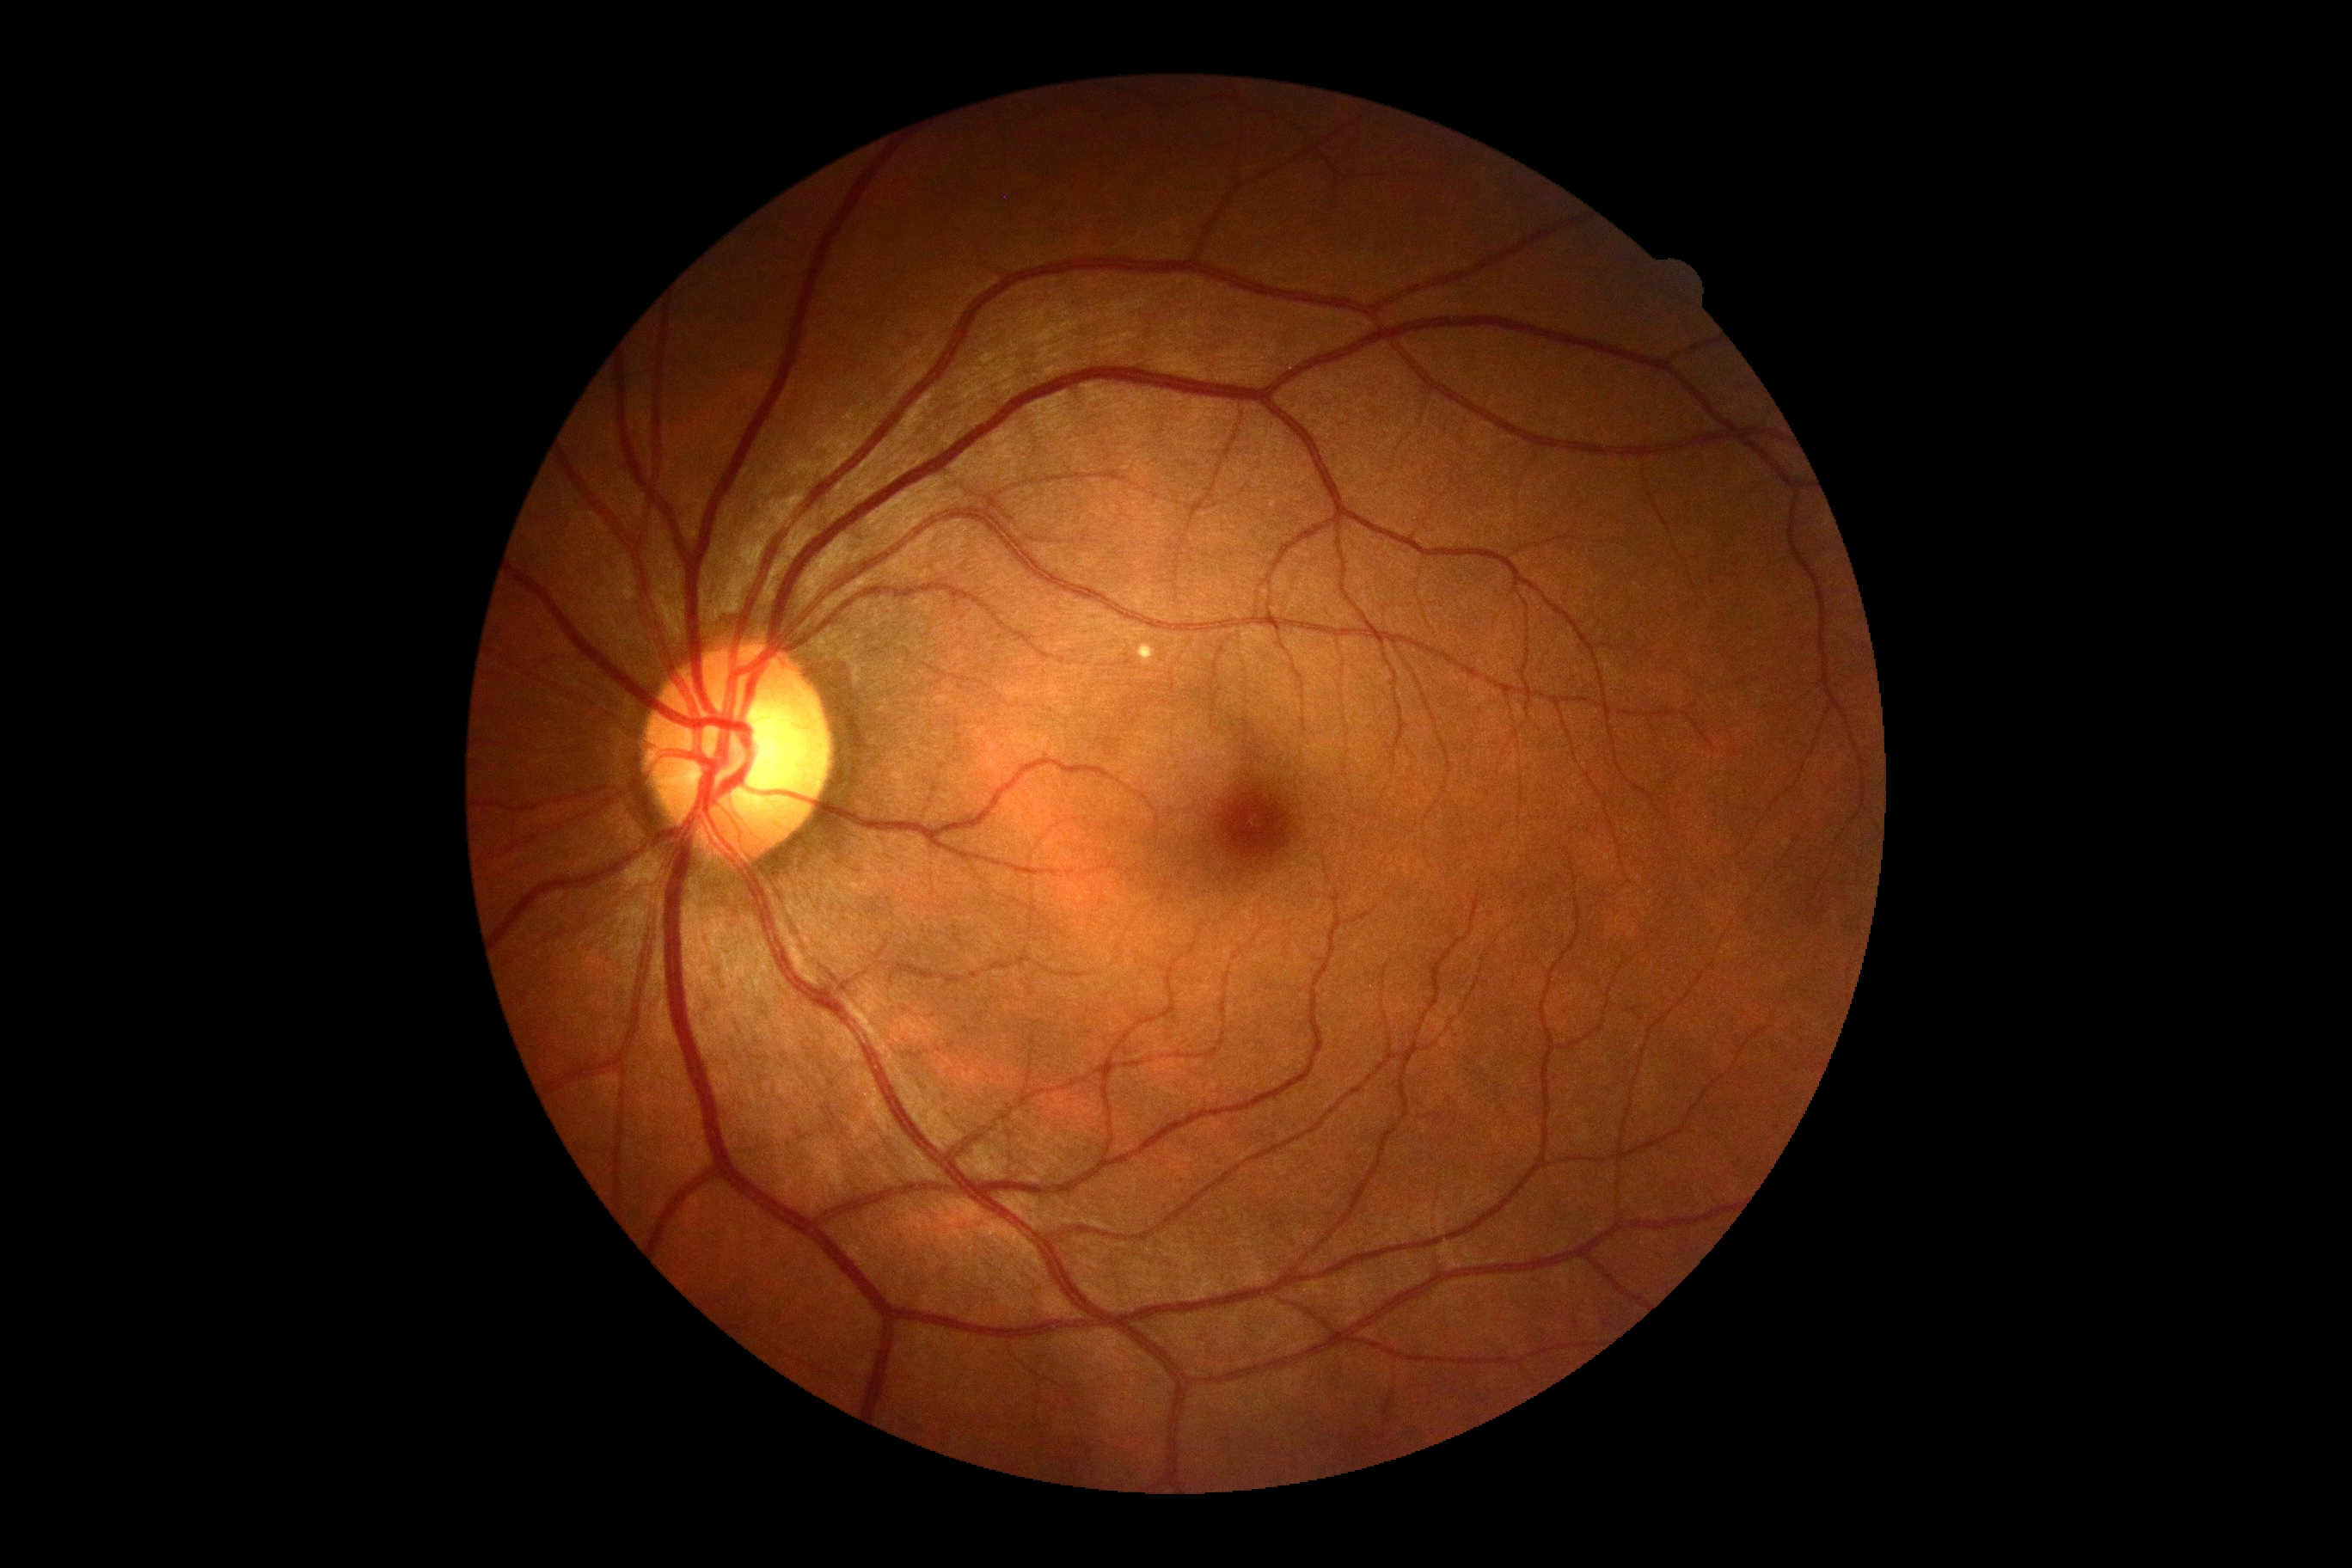

DR grade is 0/4 — no visible signs of diabetic retinopathy.